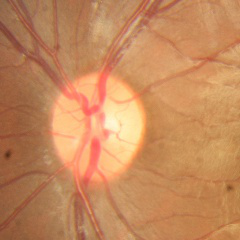 Q: Is glaucoma present?
A: No — no evidence of glaucoma.